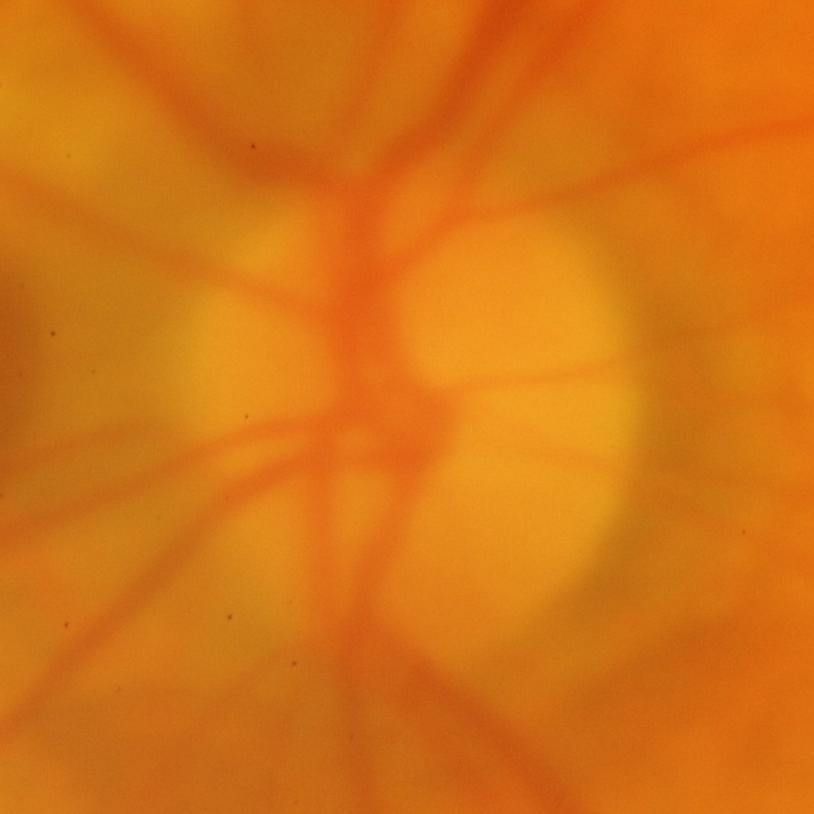
ONH-centered fundus image showing glaucomatous damage to the optic nerve.